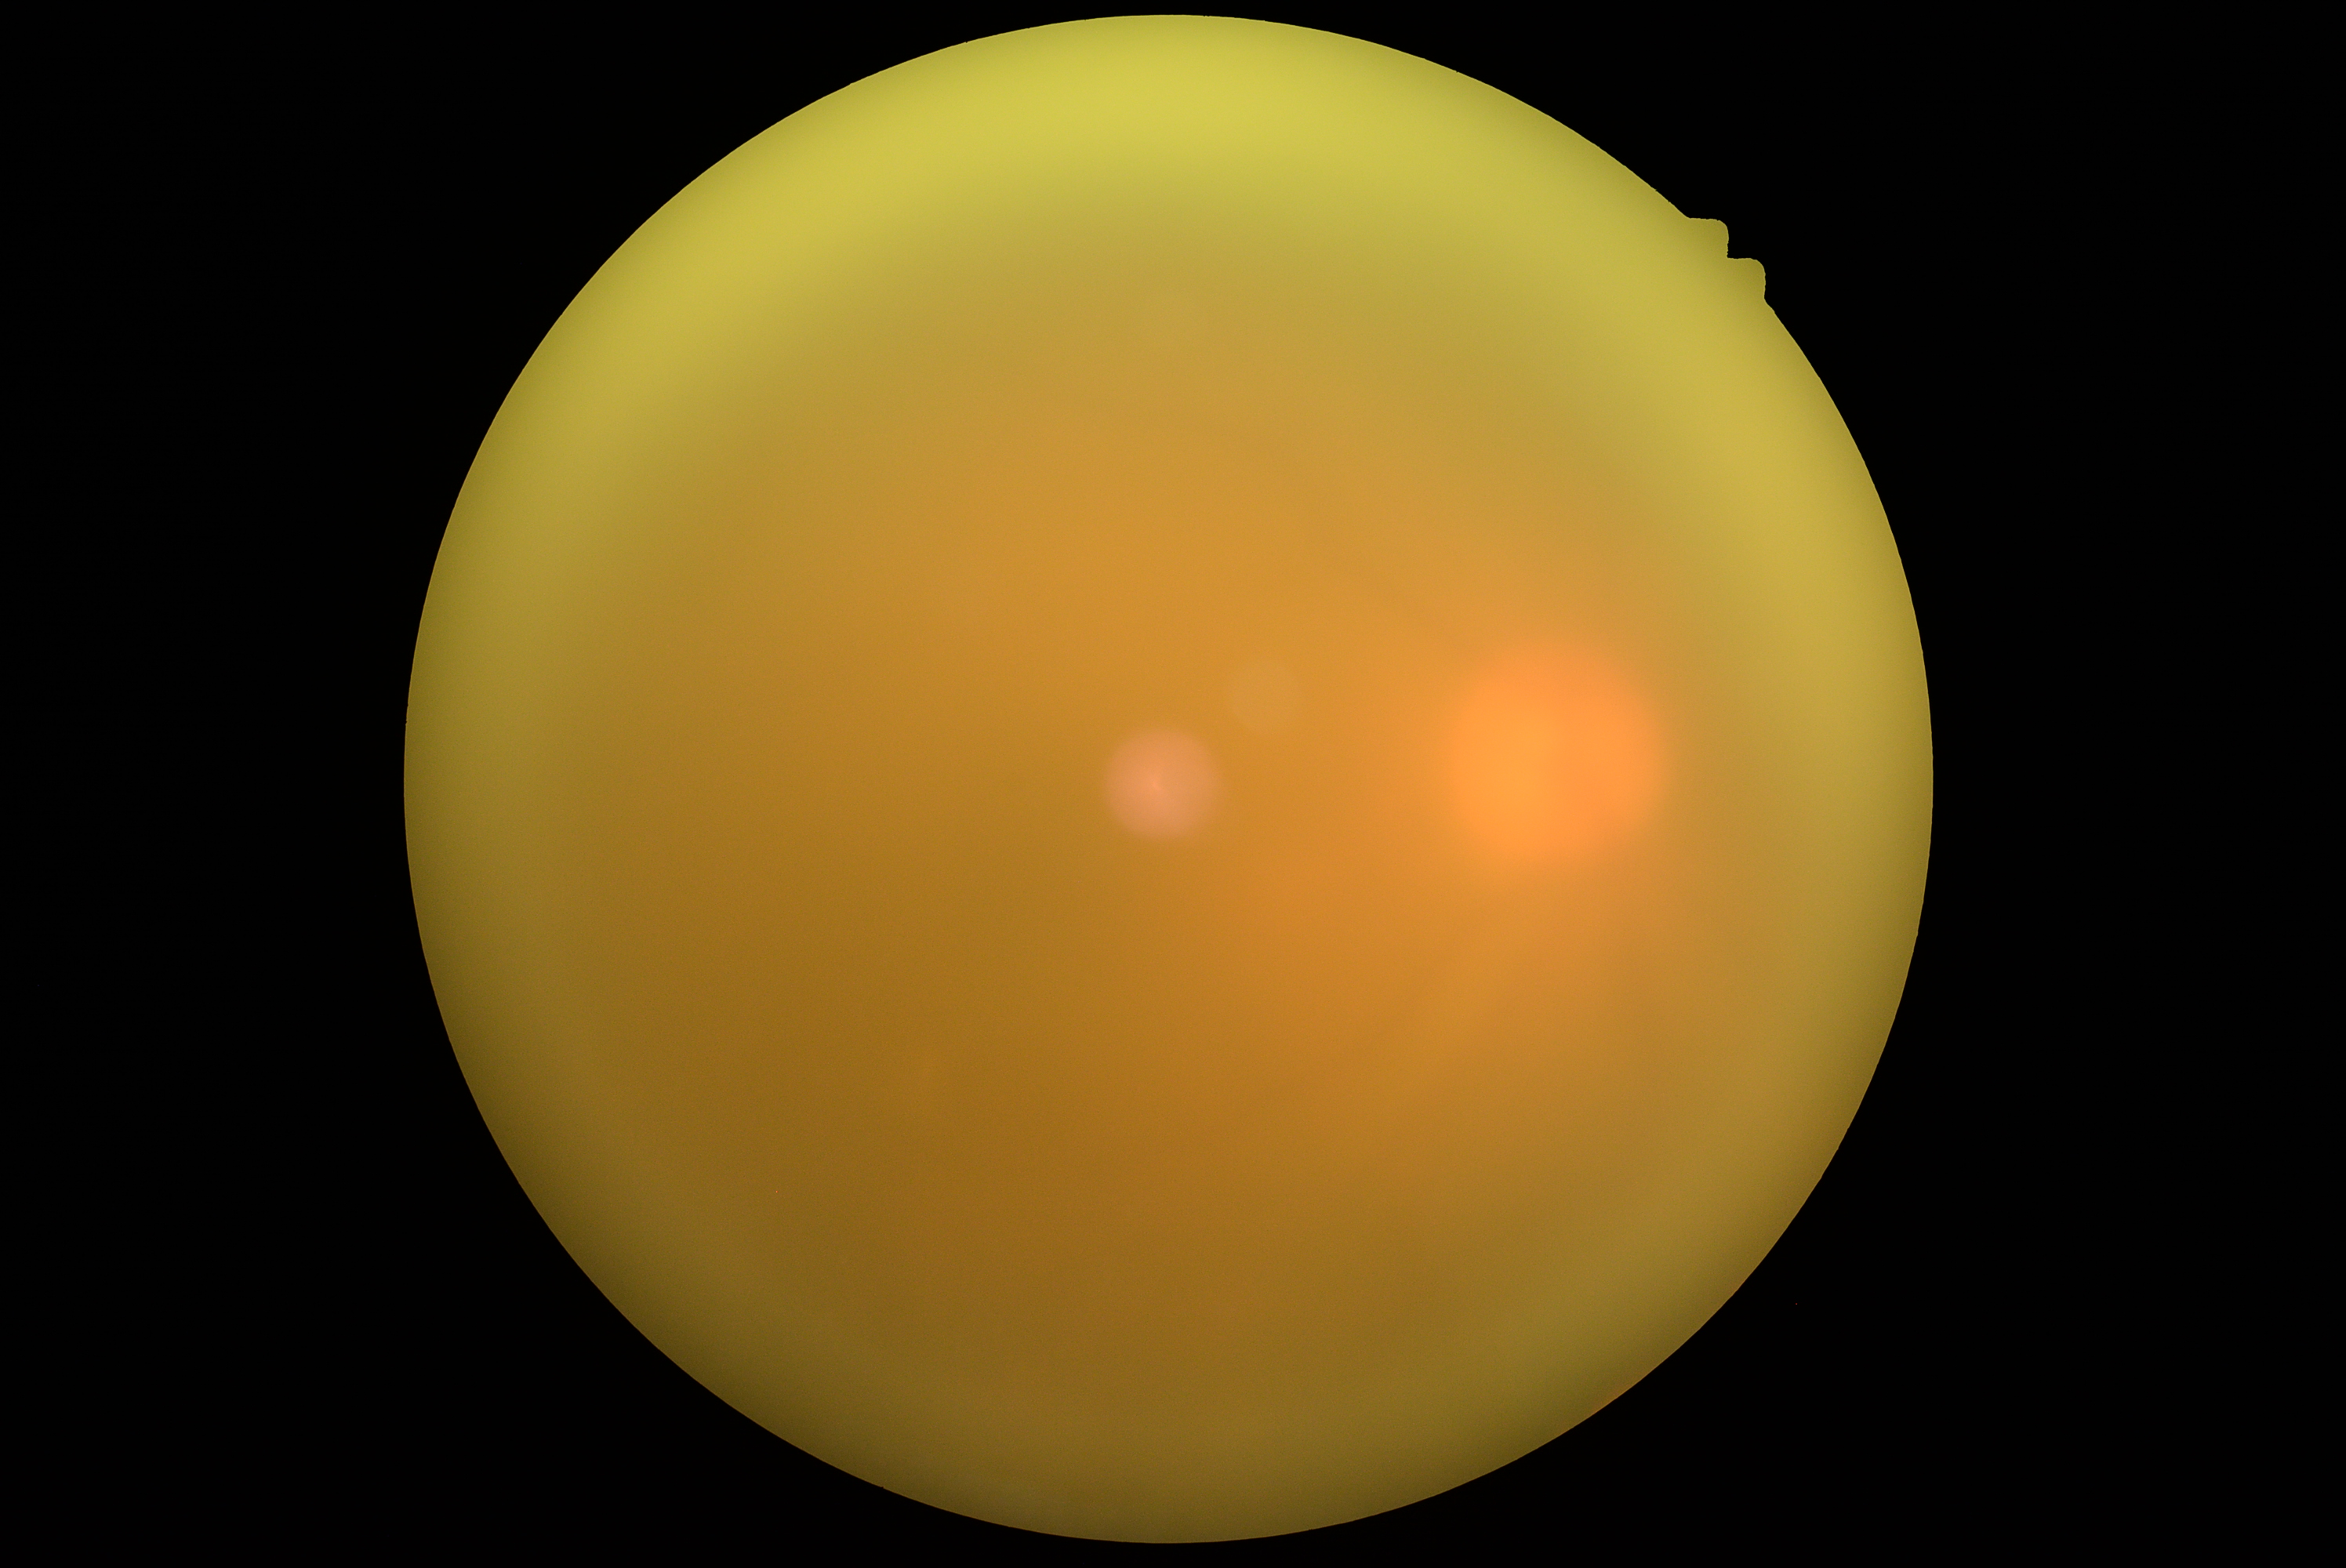
DR is ungradable. Image quality is insufficient for diabetic retinopathy assessment.